848x848; color fundus photograph; NIDEK AFC-230 fundus camera.
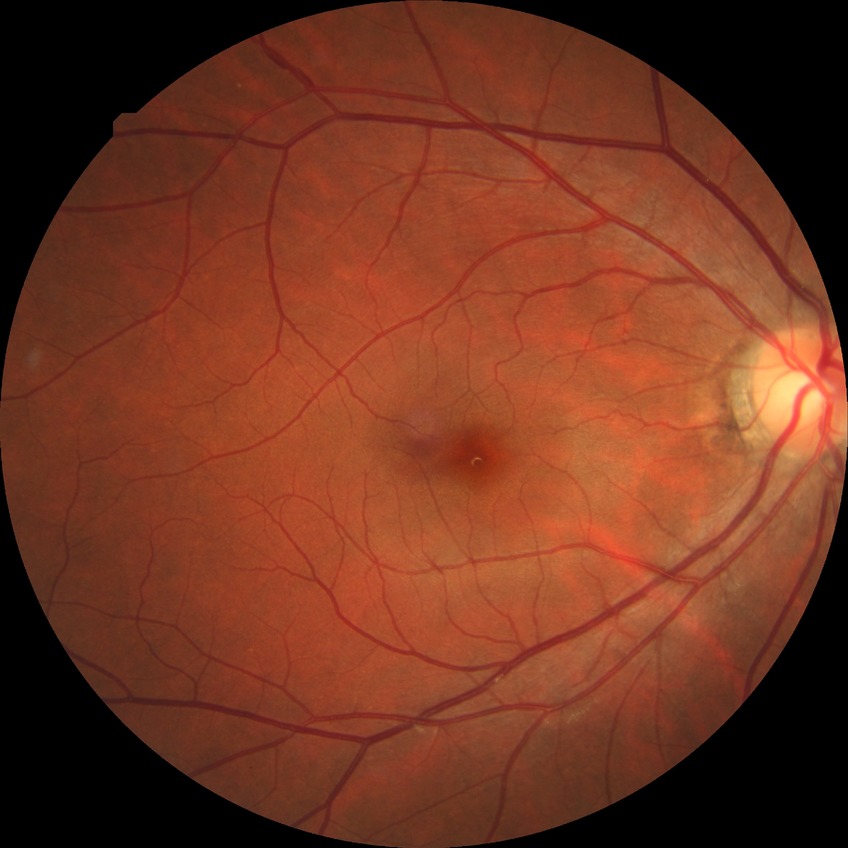

Davis grading: no diabetic retinopathy.